Fundus photo — 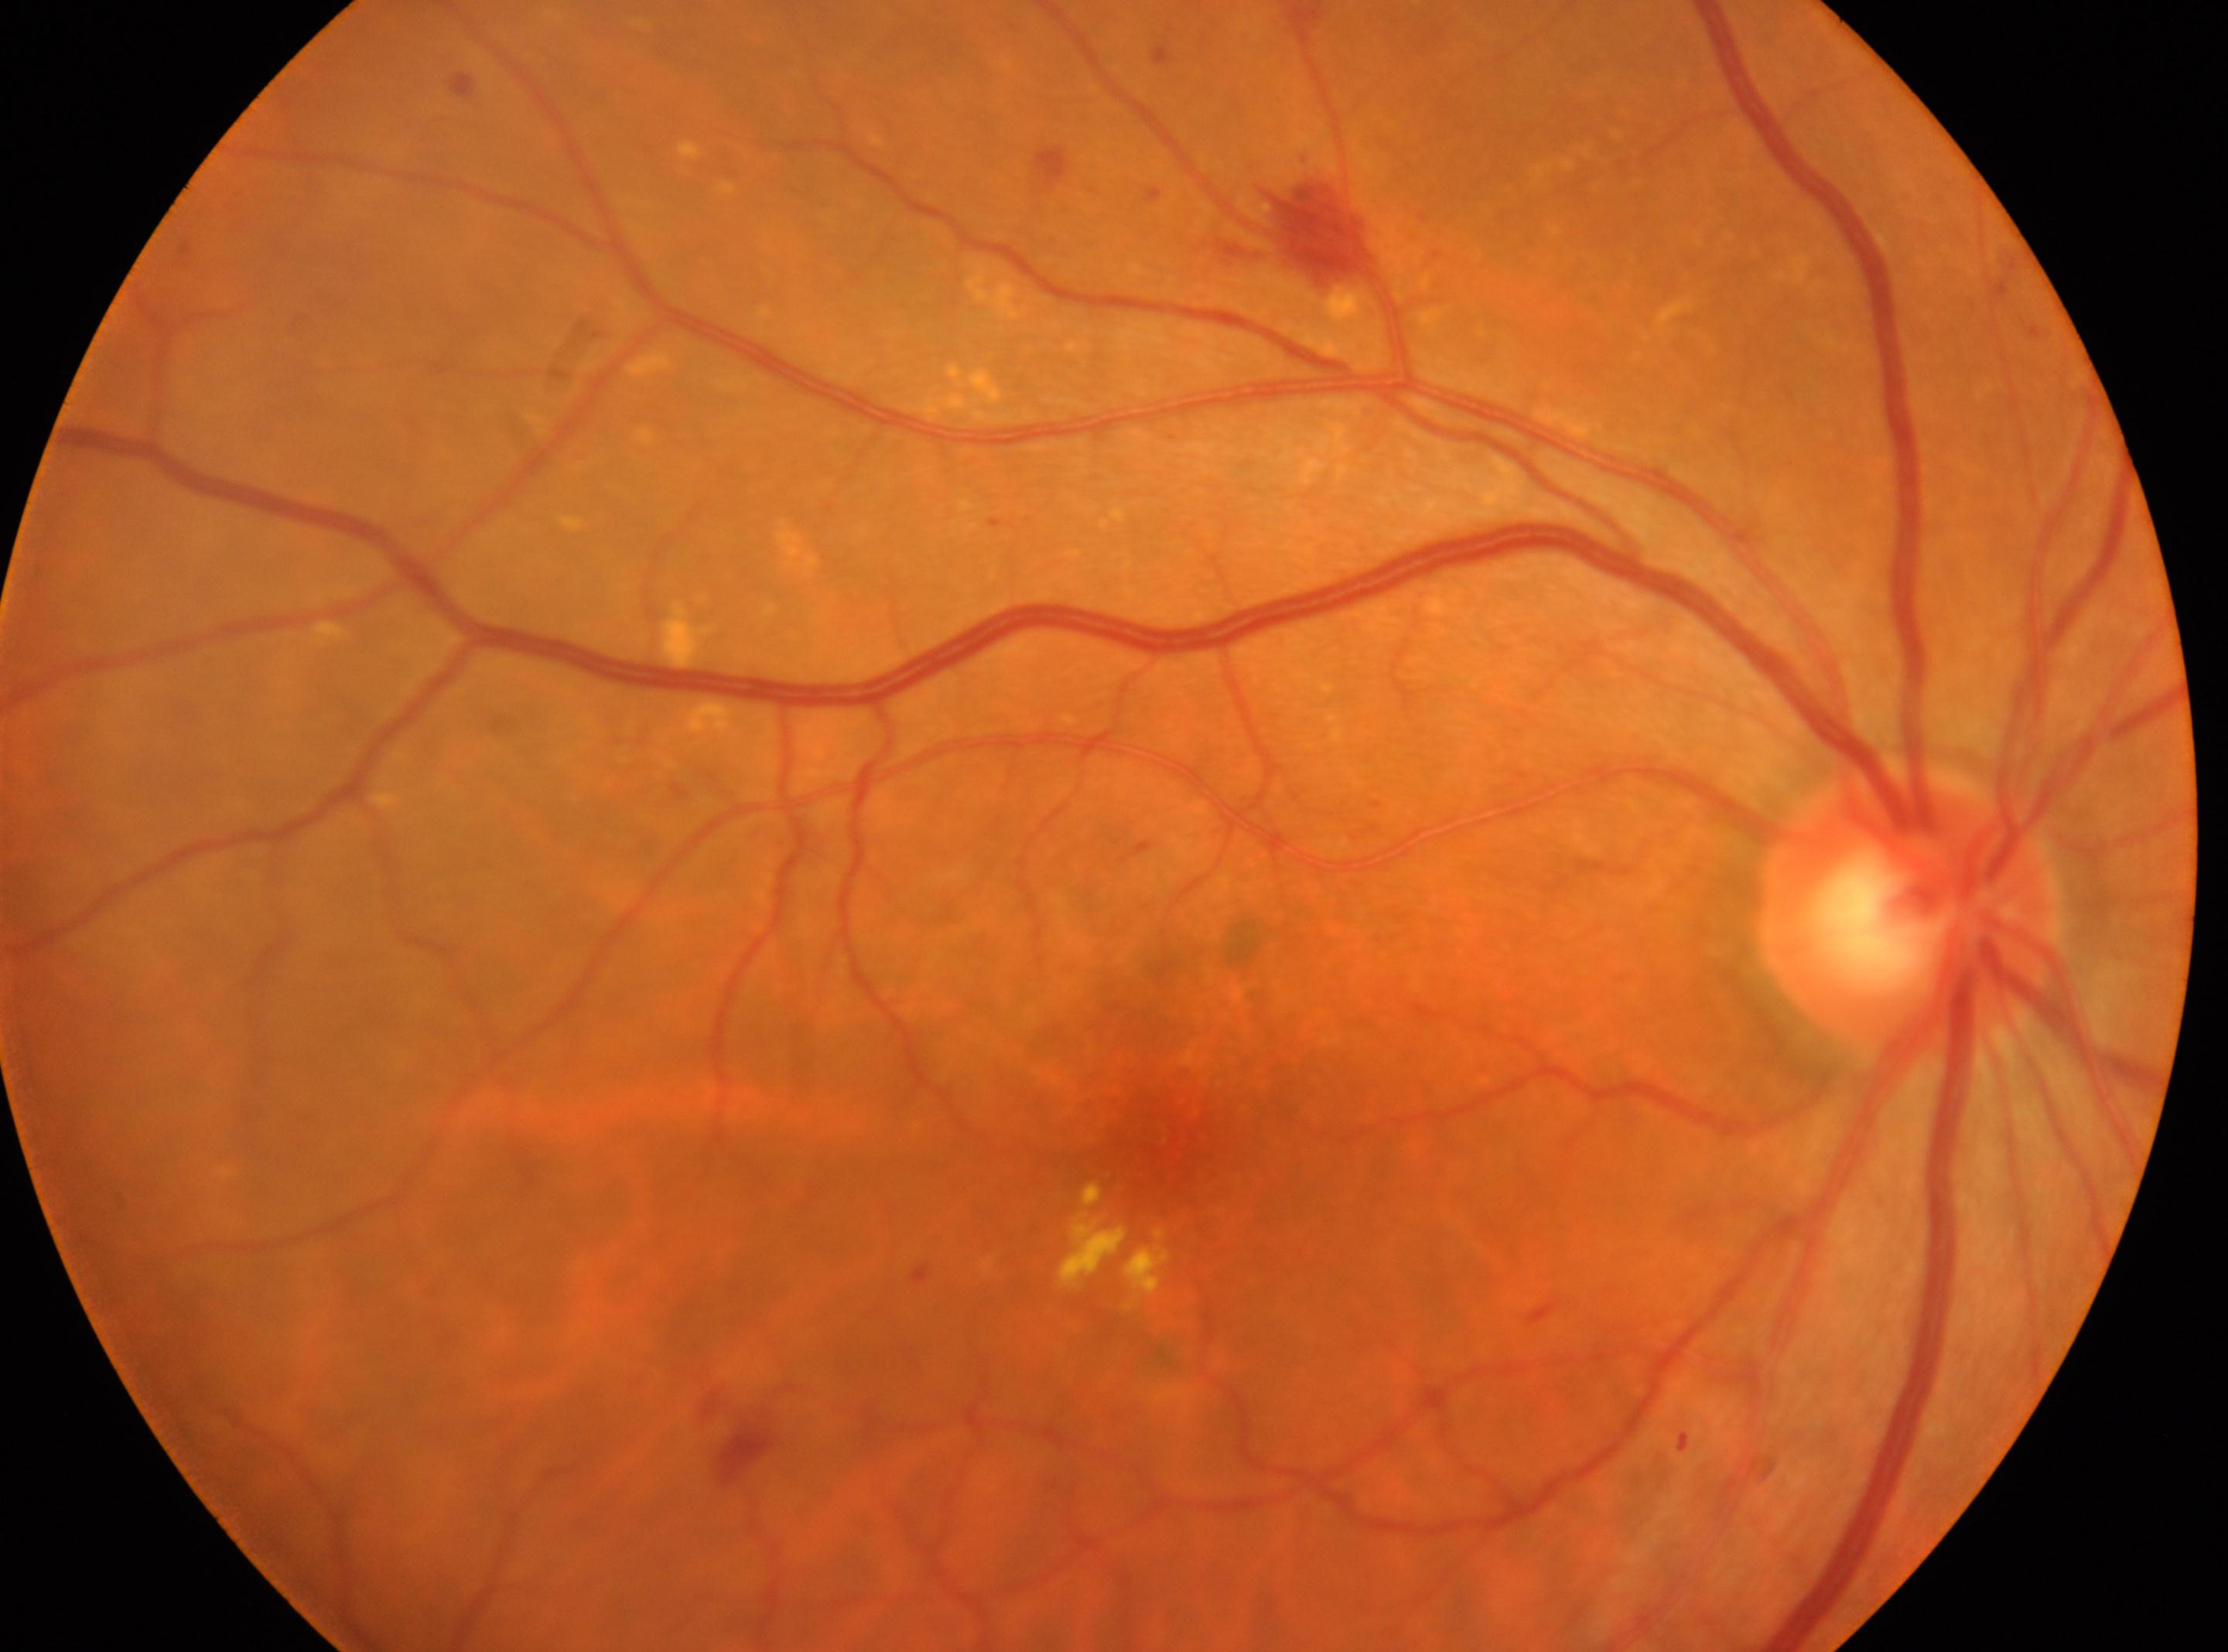 Retinopathy grade: 2.
Fovea centralis: (x=1148, y=1132).
Eye: right eye.
ONH located at (x=1909, y=908).
The retinopathy is classified as non-proliferative diabetic retinopathy.